1932x1932px:
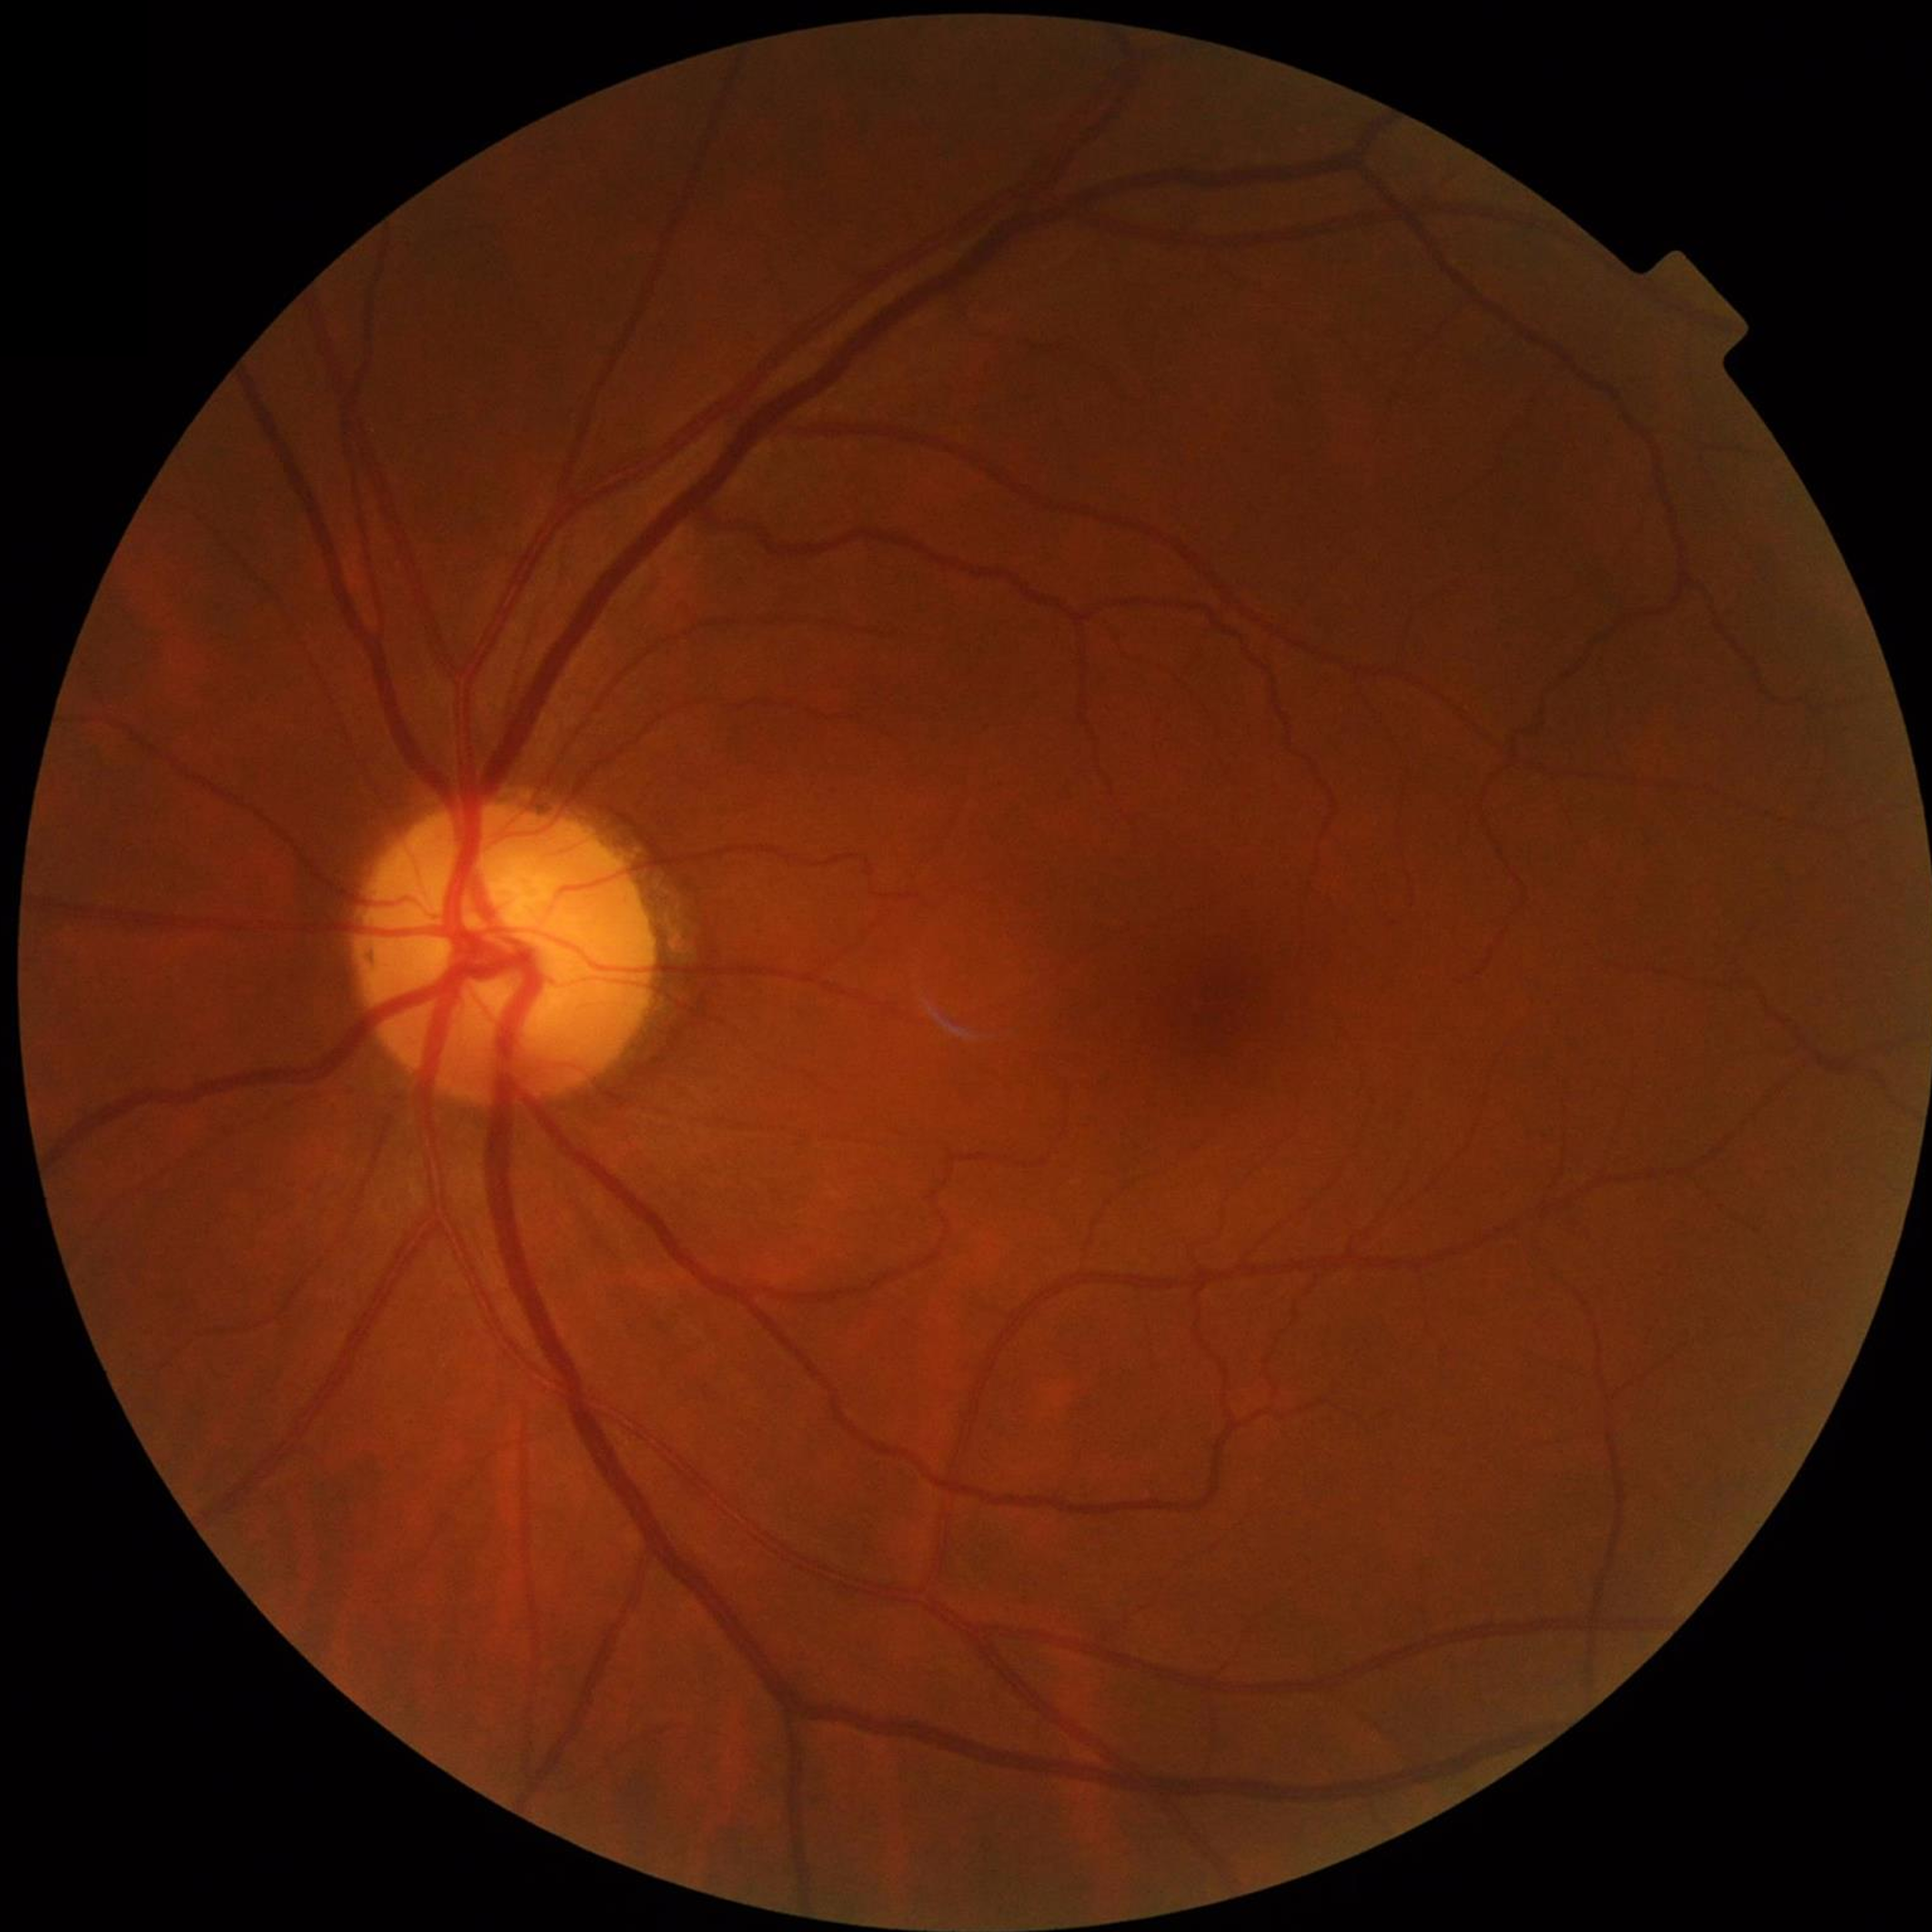

Disease = no AMD, DR, or glaucomatous findings